Camera: Clarity RetCam 3 (130° FOV); 640 by 480 pixels; infant wide-field fundus photograph:
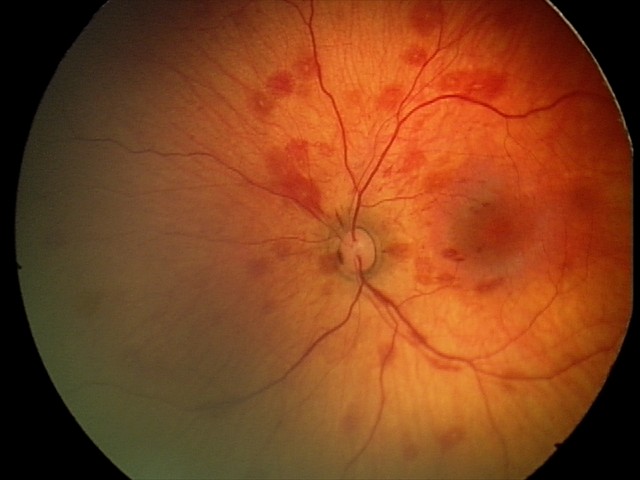
Assessment = retinal hemorrhages.